Retinal fundus photograph; mydriatic (tropicamide phenylephrine 1.0%); macula at the center of the field
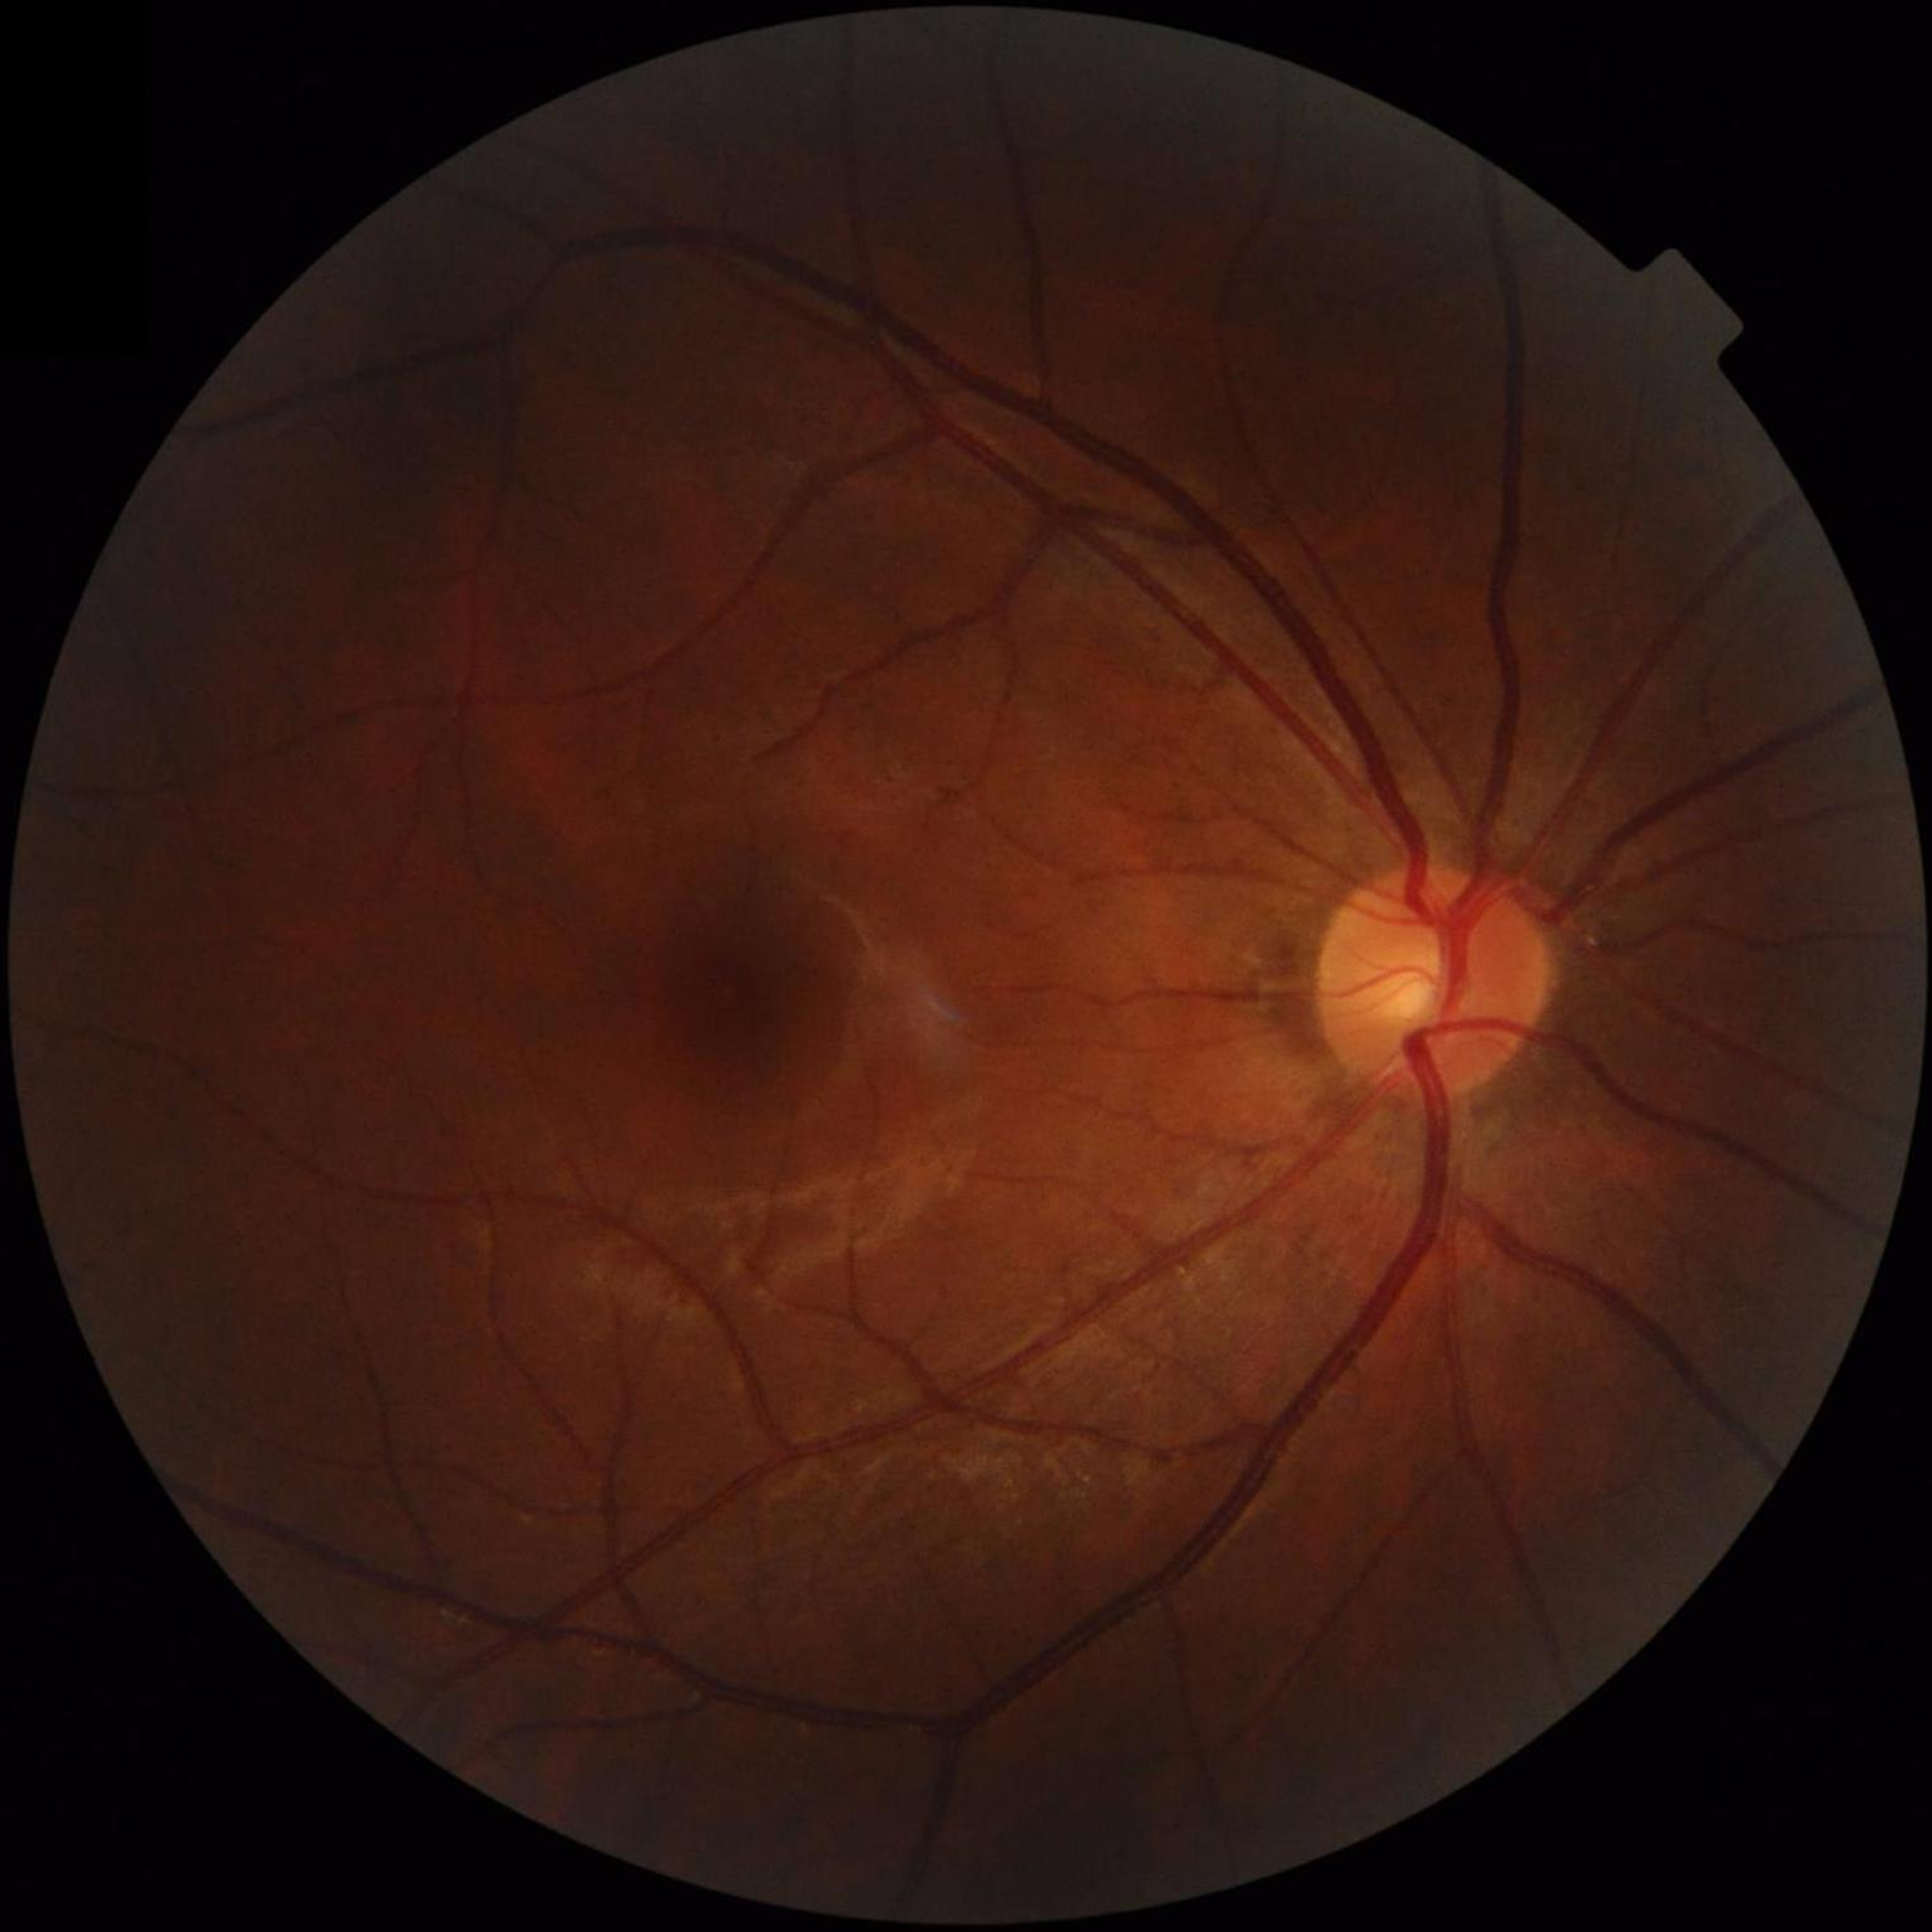 No findings of AMD, diabetic retinopathy, or glaucoma. Image quality: issues noted — illumination/color distortion.